45-degree field of view · 2352 by 1568 pixels · retinal fundus photograph: 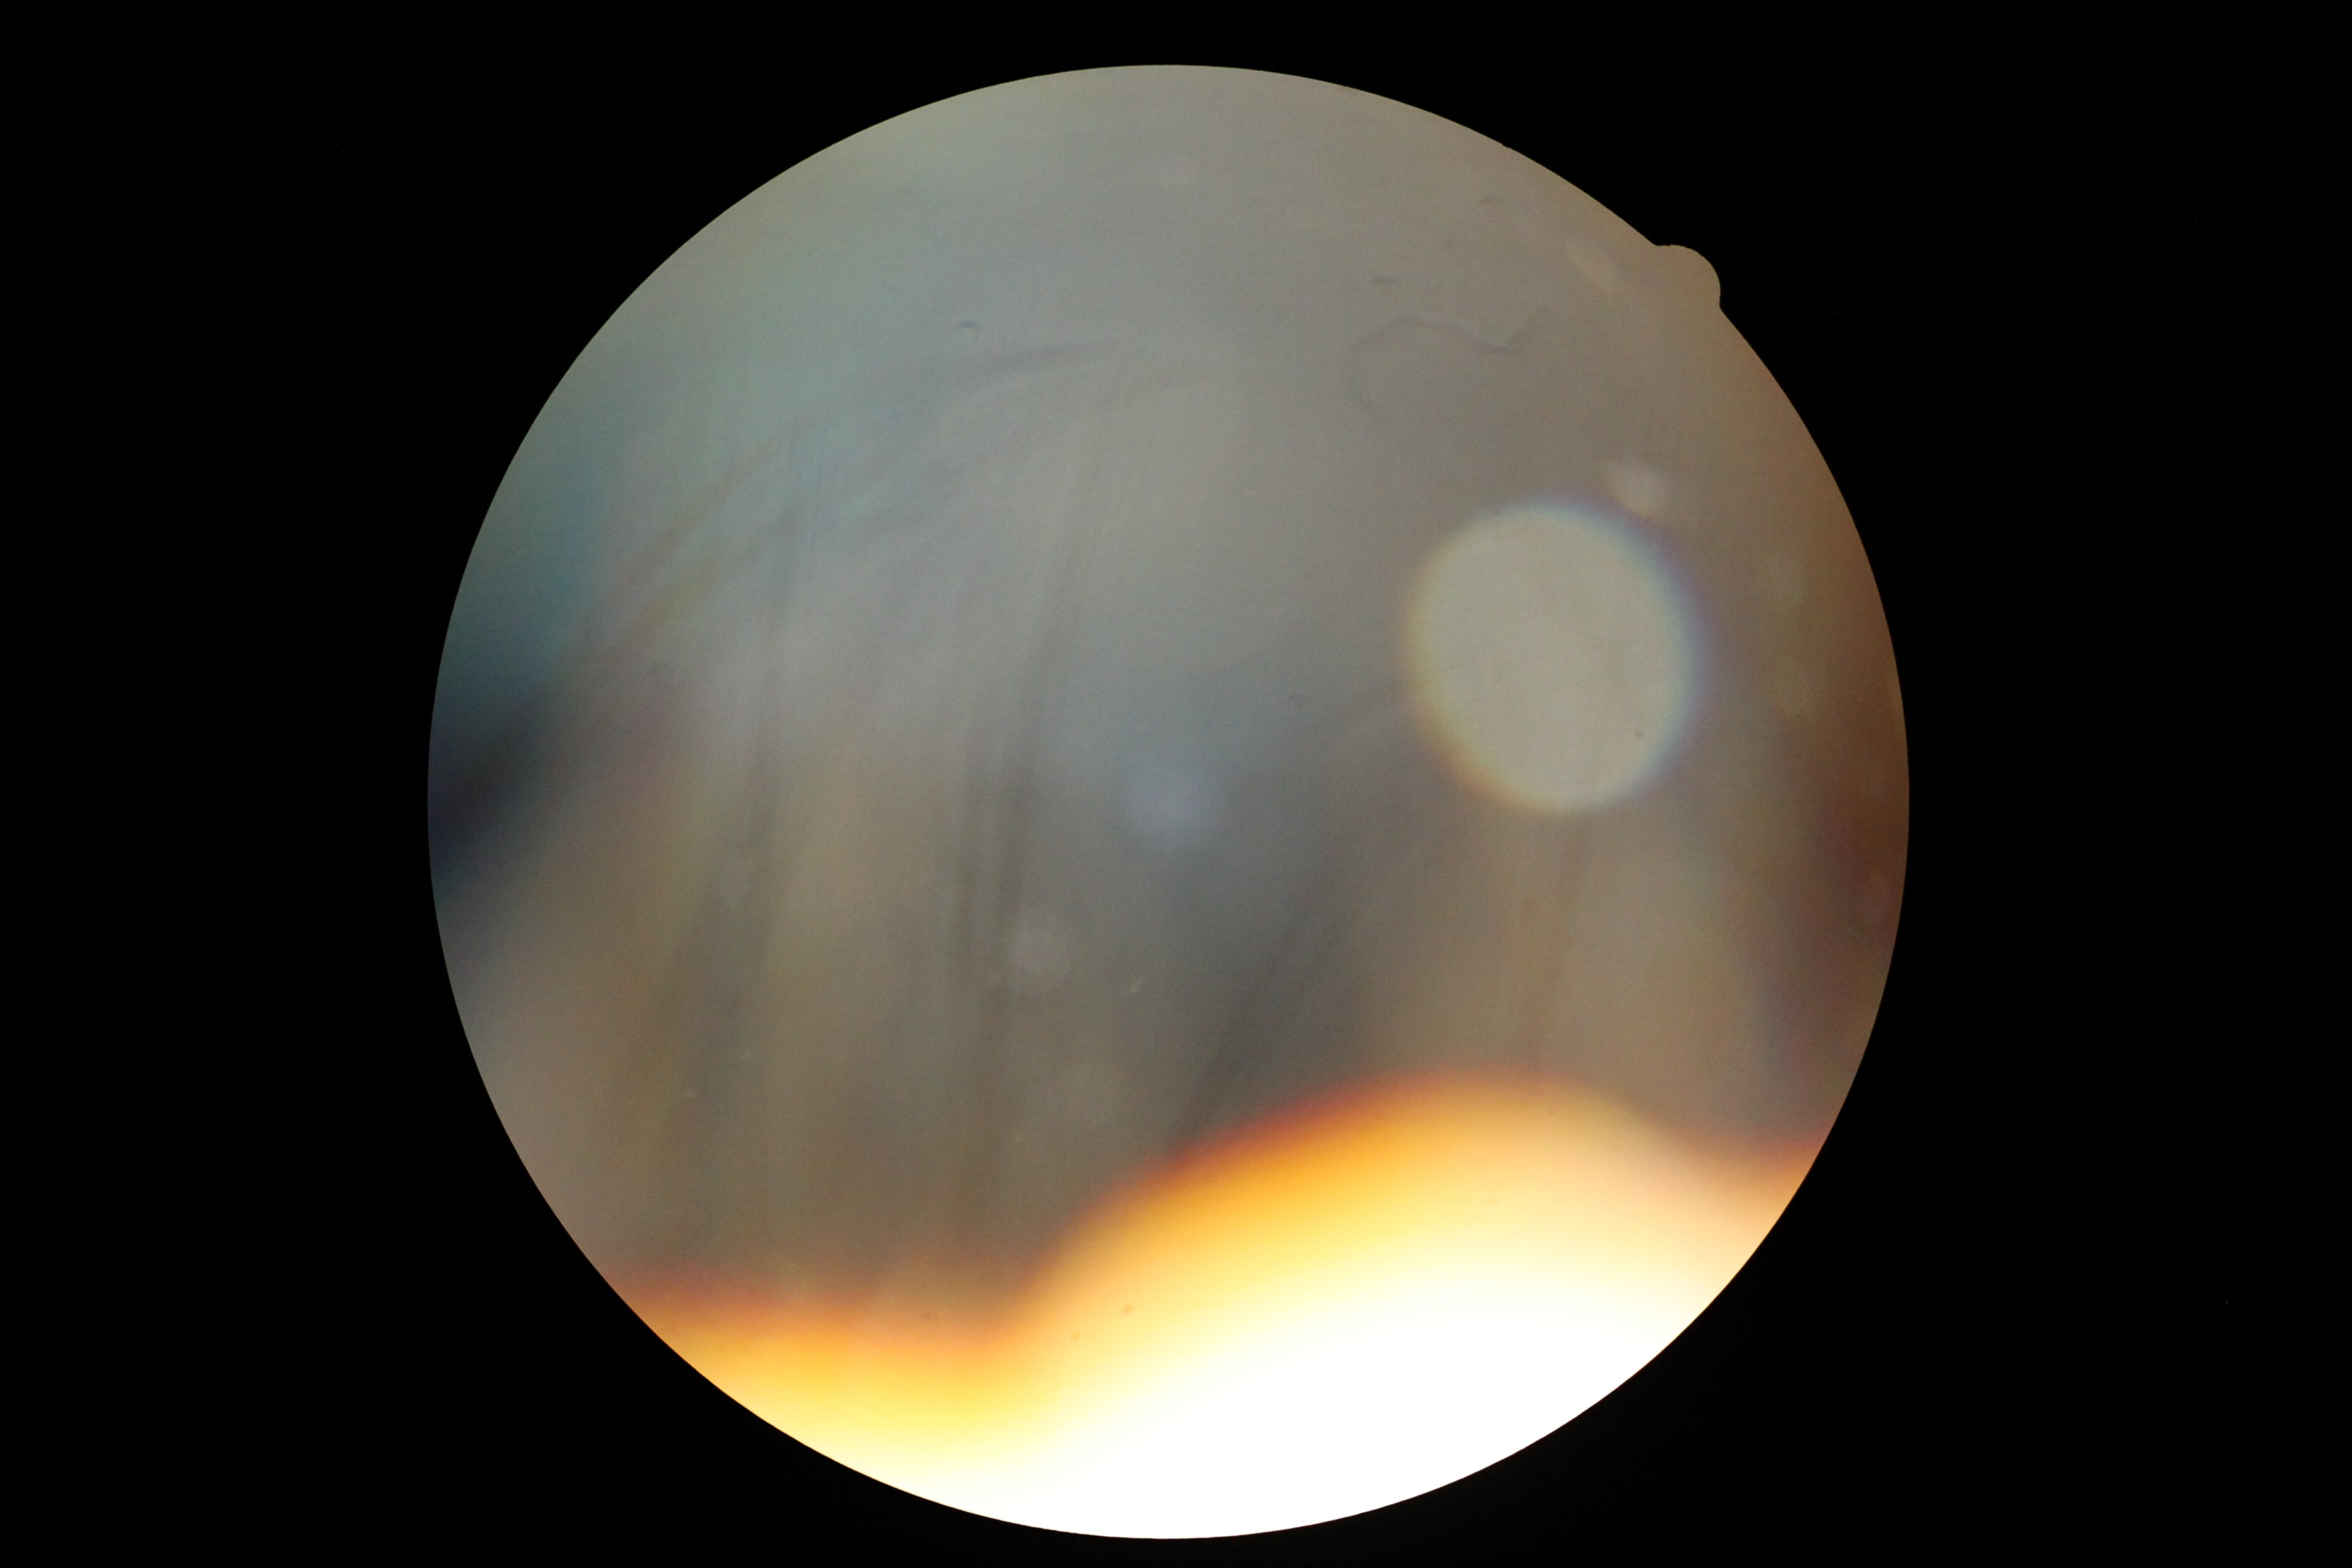

{
  "quality": "too poor for DR grading",
  "dr_grade": "ungradable"
}